Color fundus photograph. DR severity per modified Davis staging. 45-degree field of view
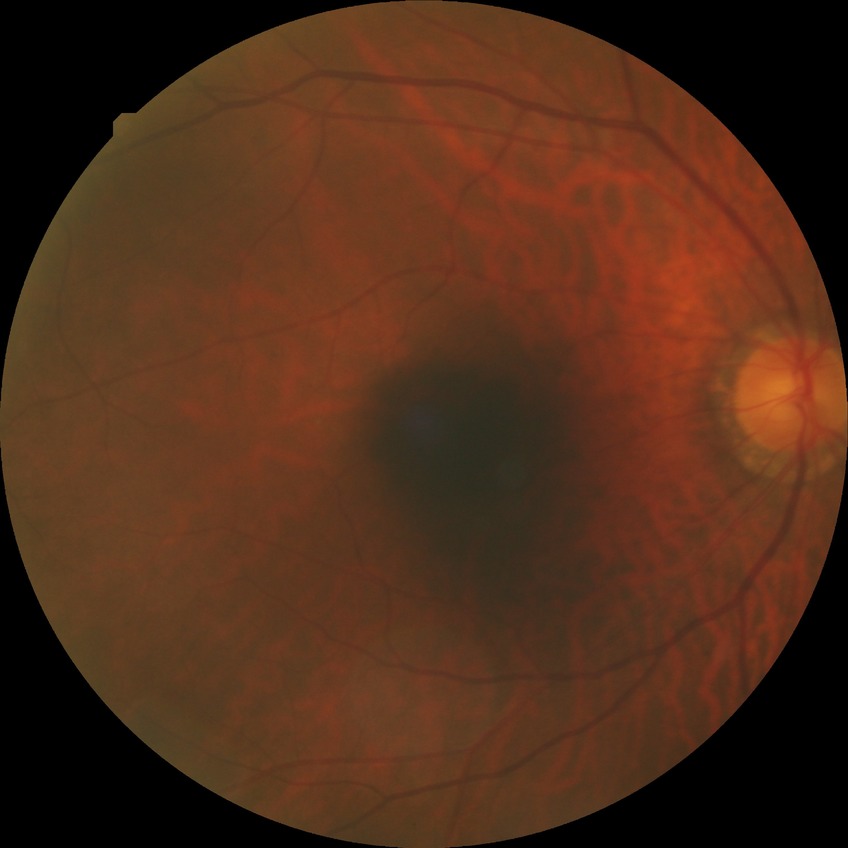 Diabetic retinopathy (DR) is SDR (simple diabetic retinopathy).